45° field of view:
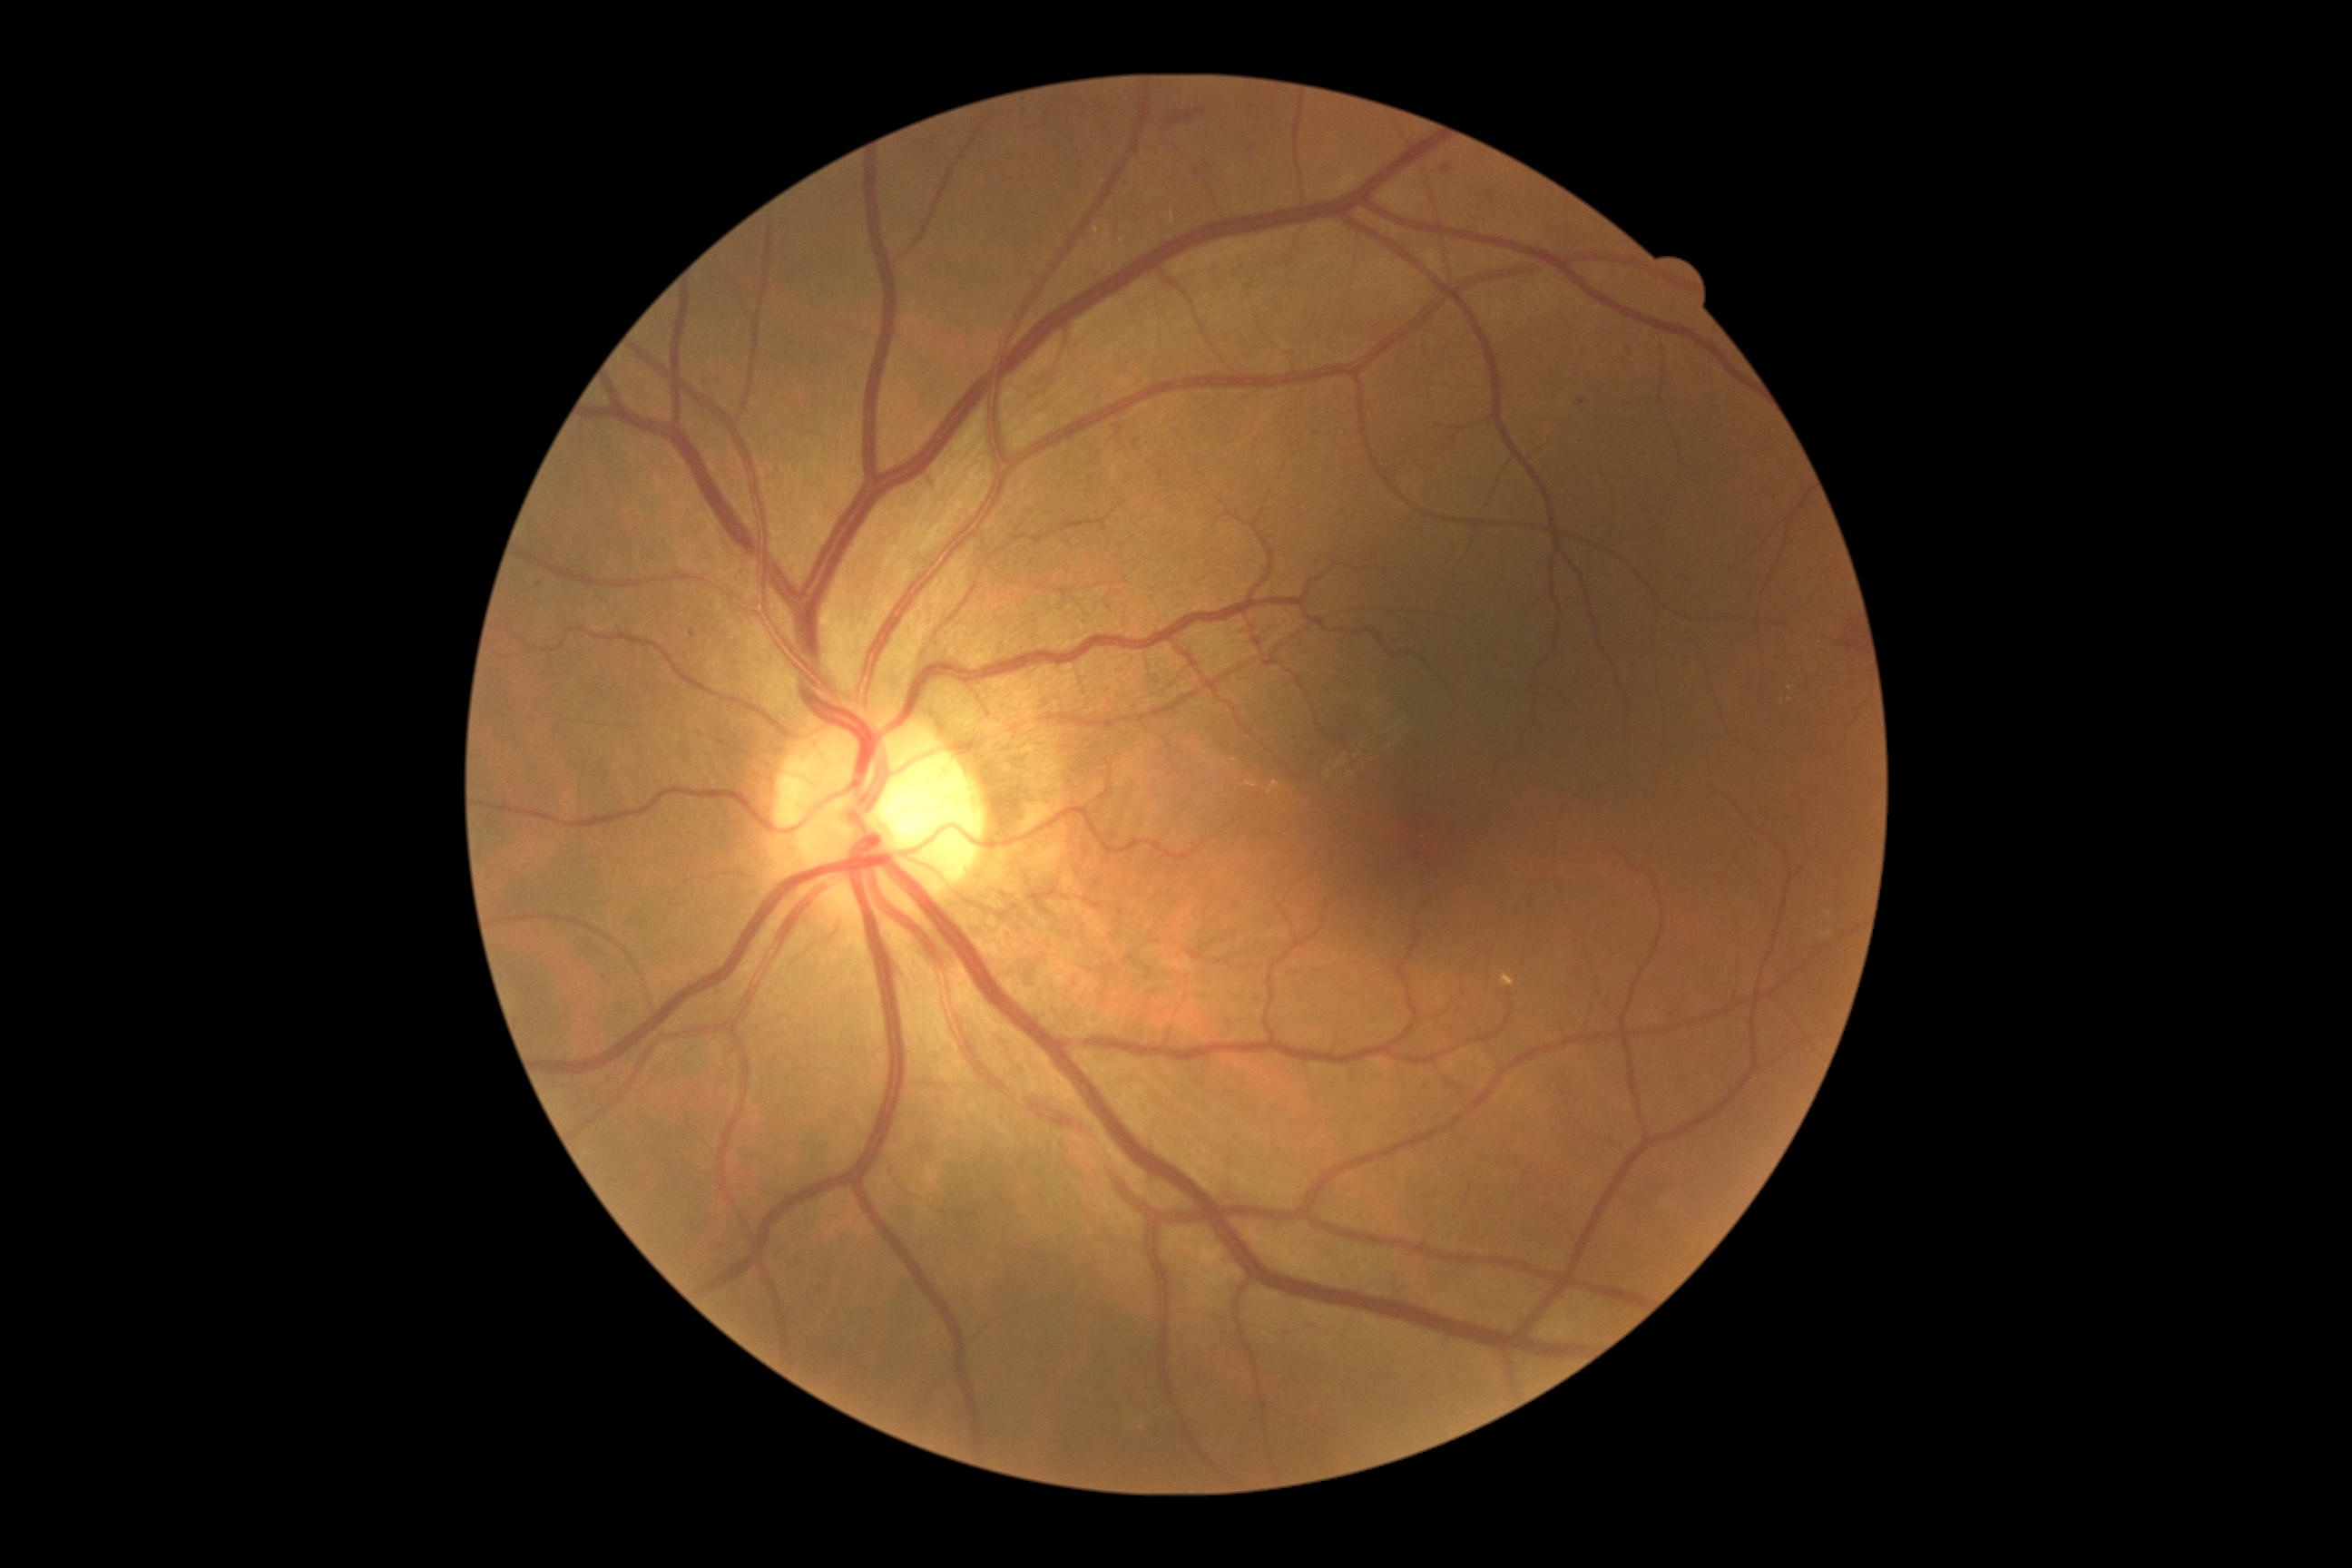 * DR class — non-proliferative diabetic retinopathy
* diabetic retinopathy severity — grade 2 (moderate NPDR)